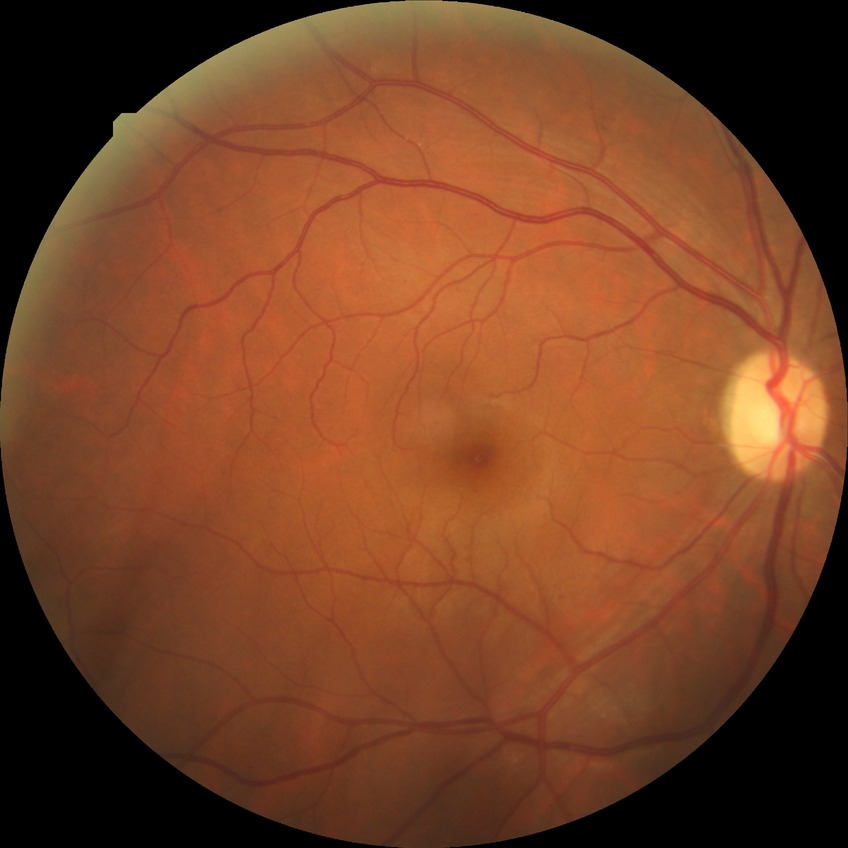

Diabetic retinopathy (DR): NDR (no diabetic retinopathy).